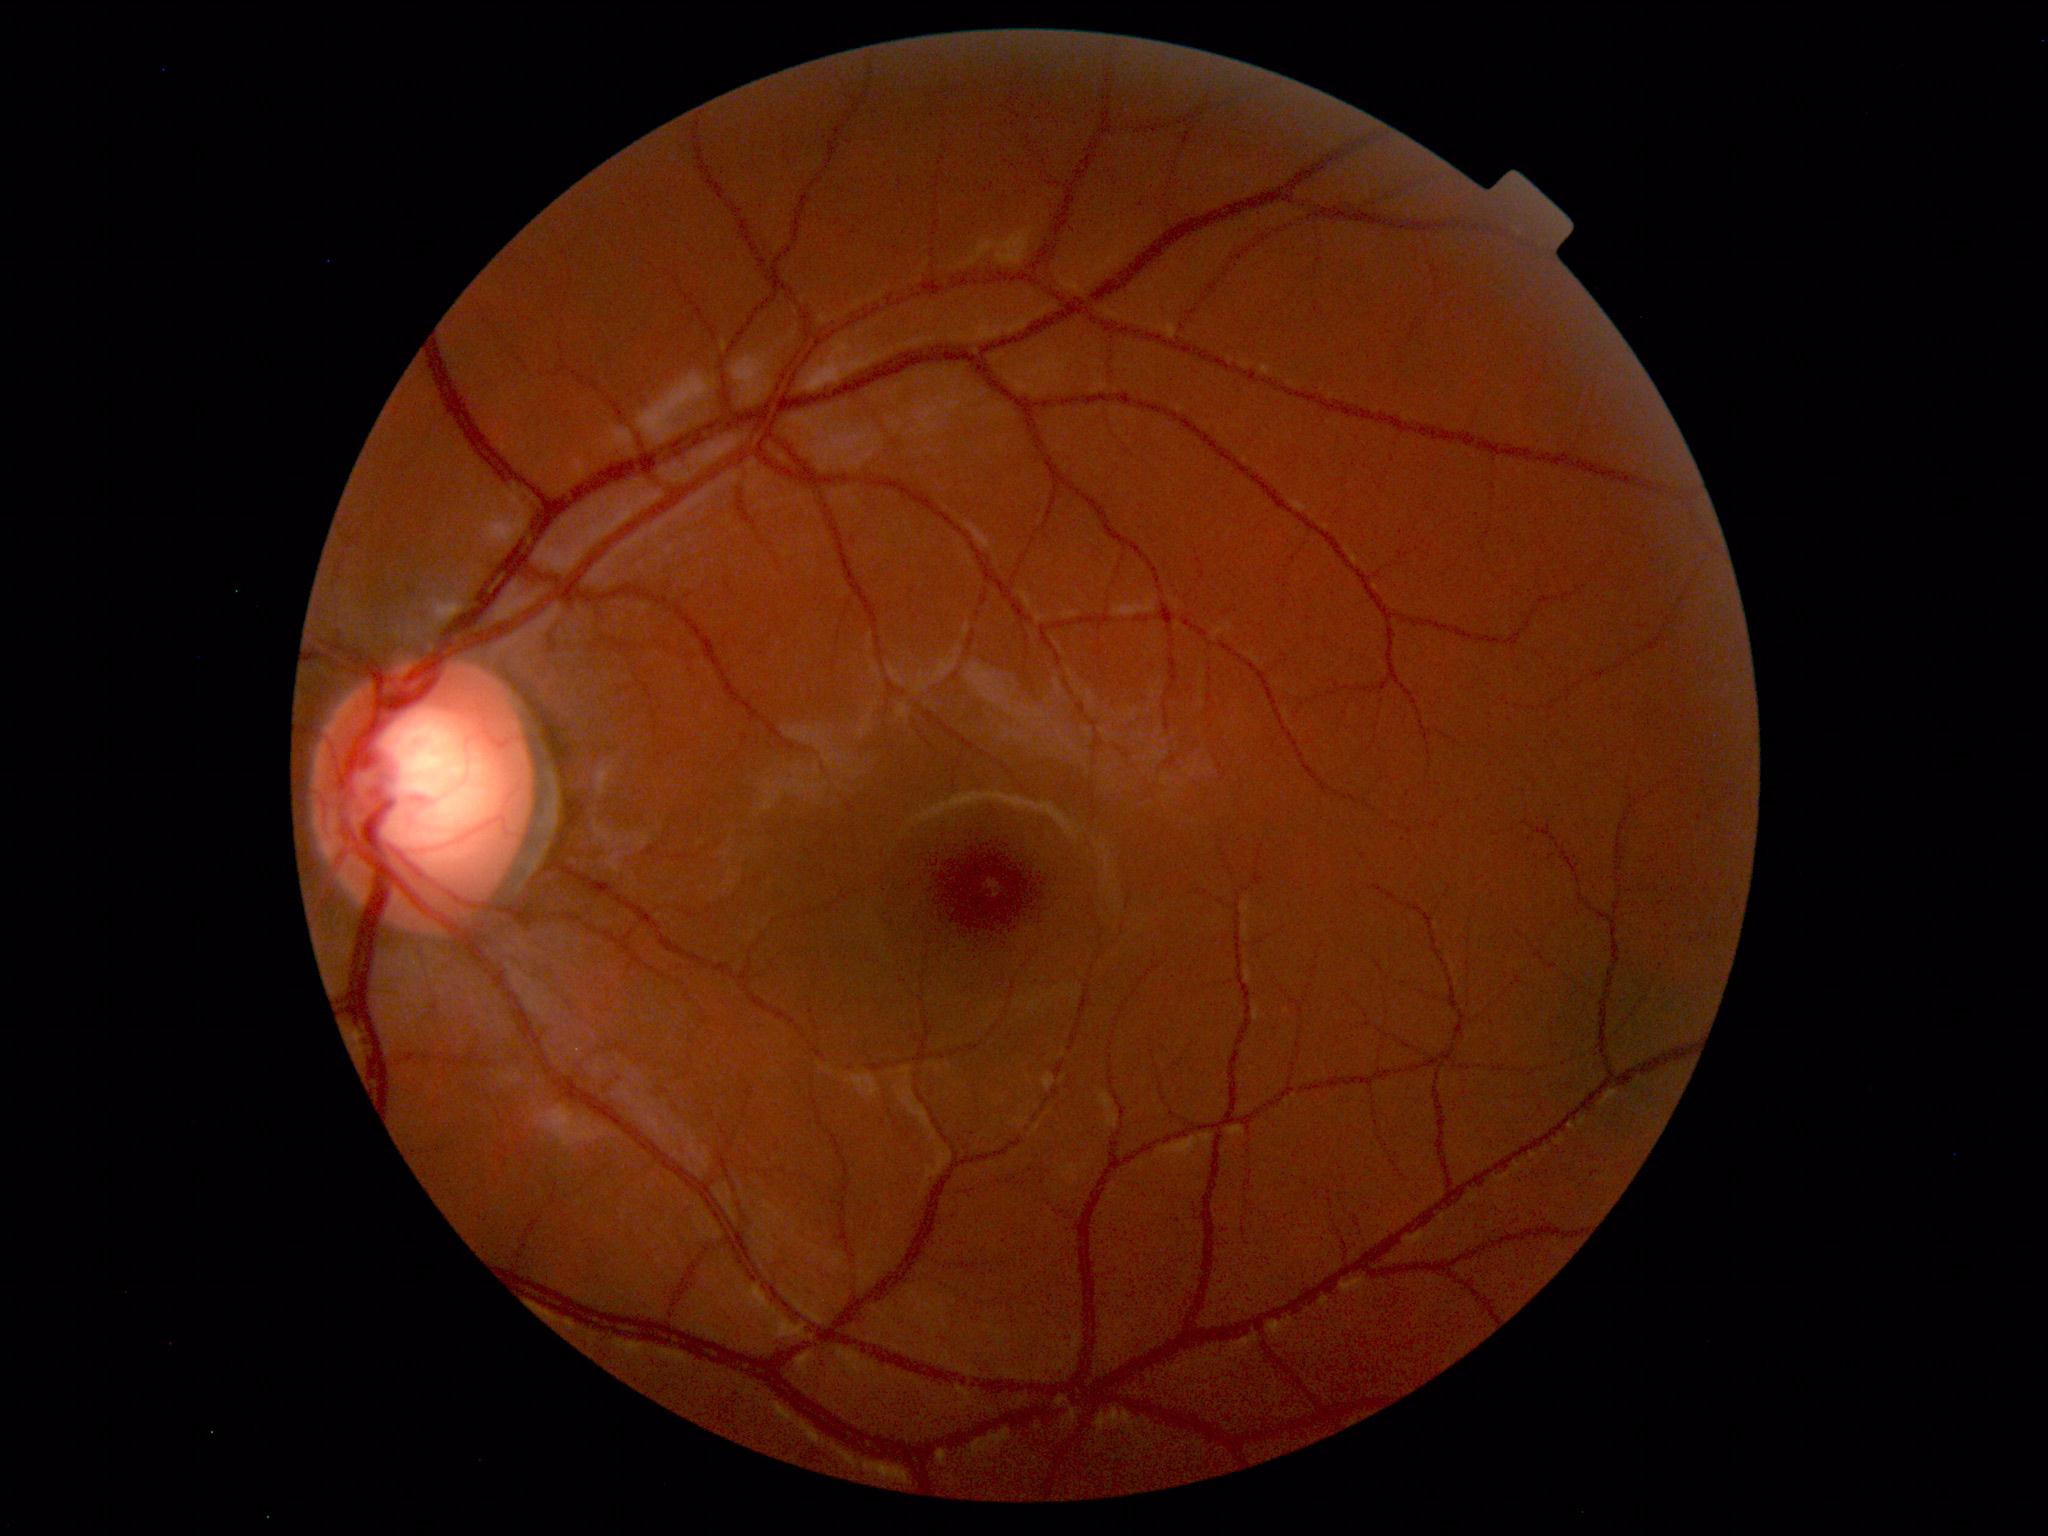 Findings: none. Normal fundus.